Color fundus photograph: 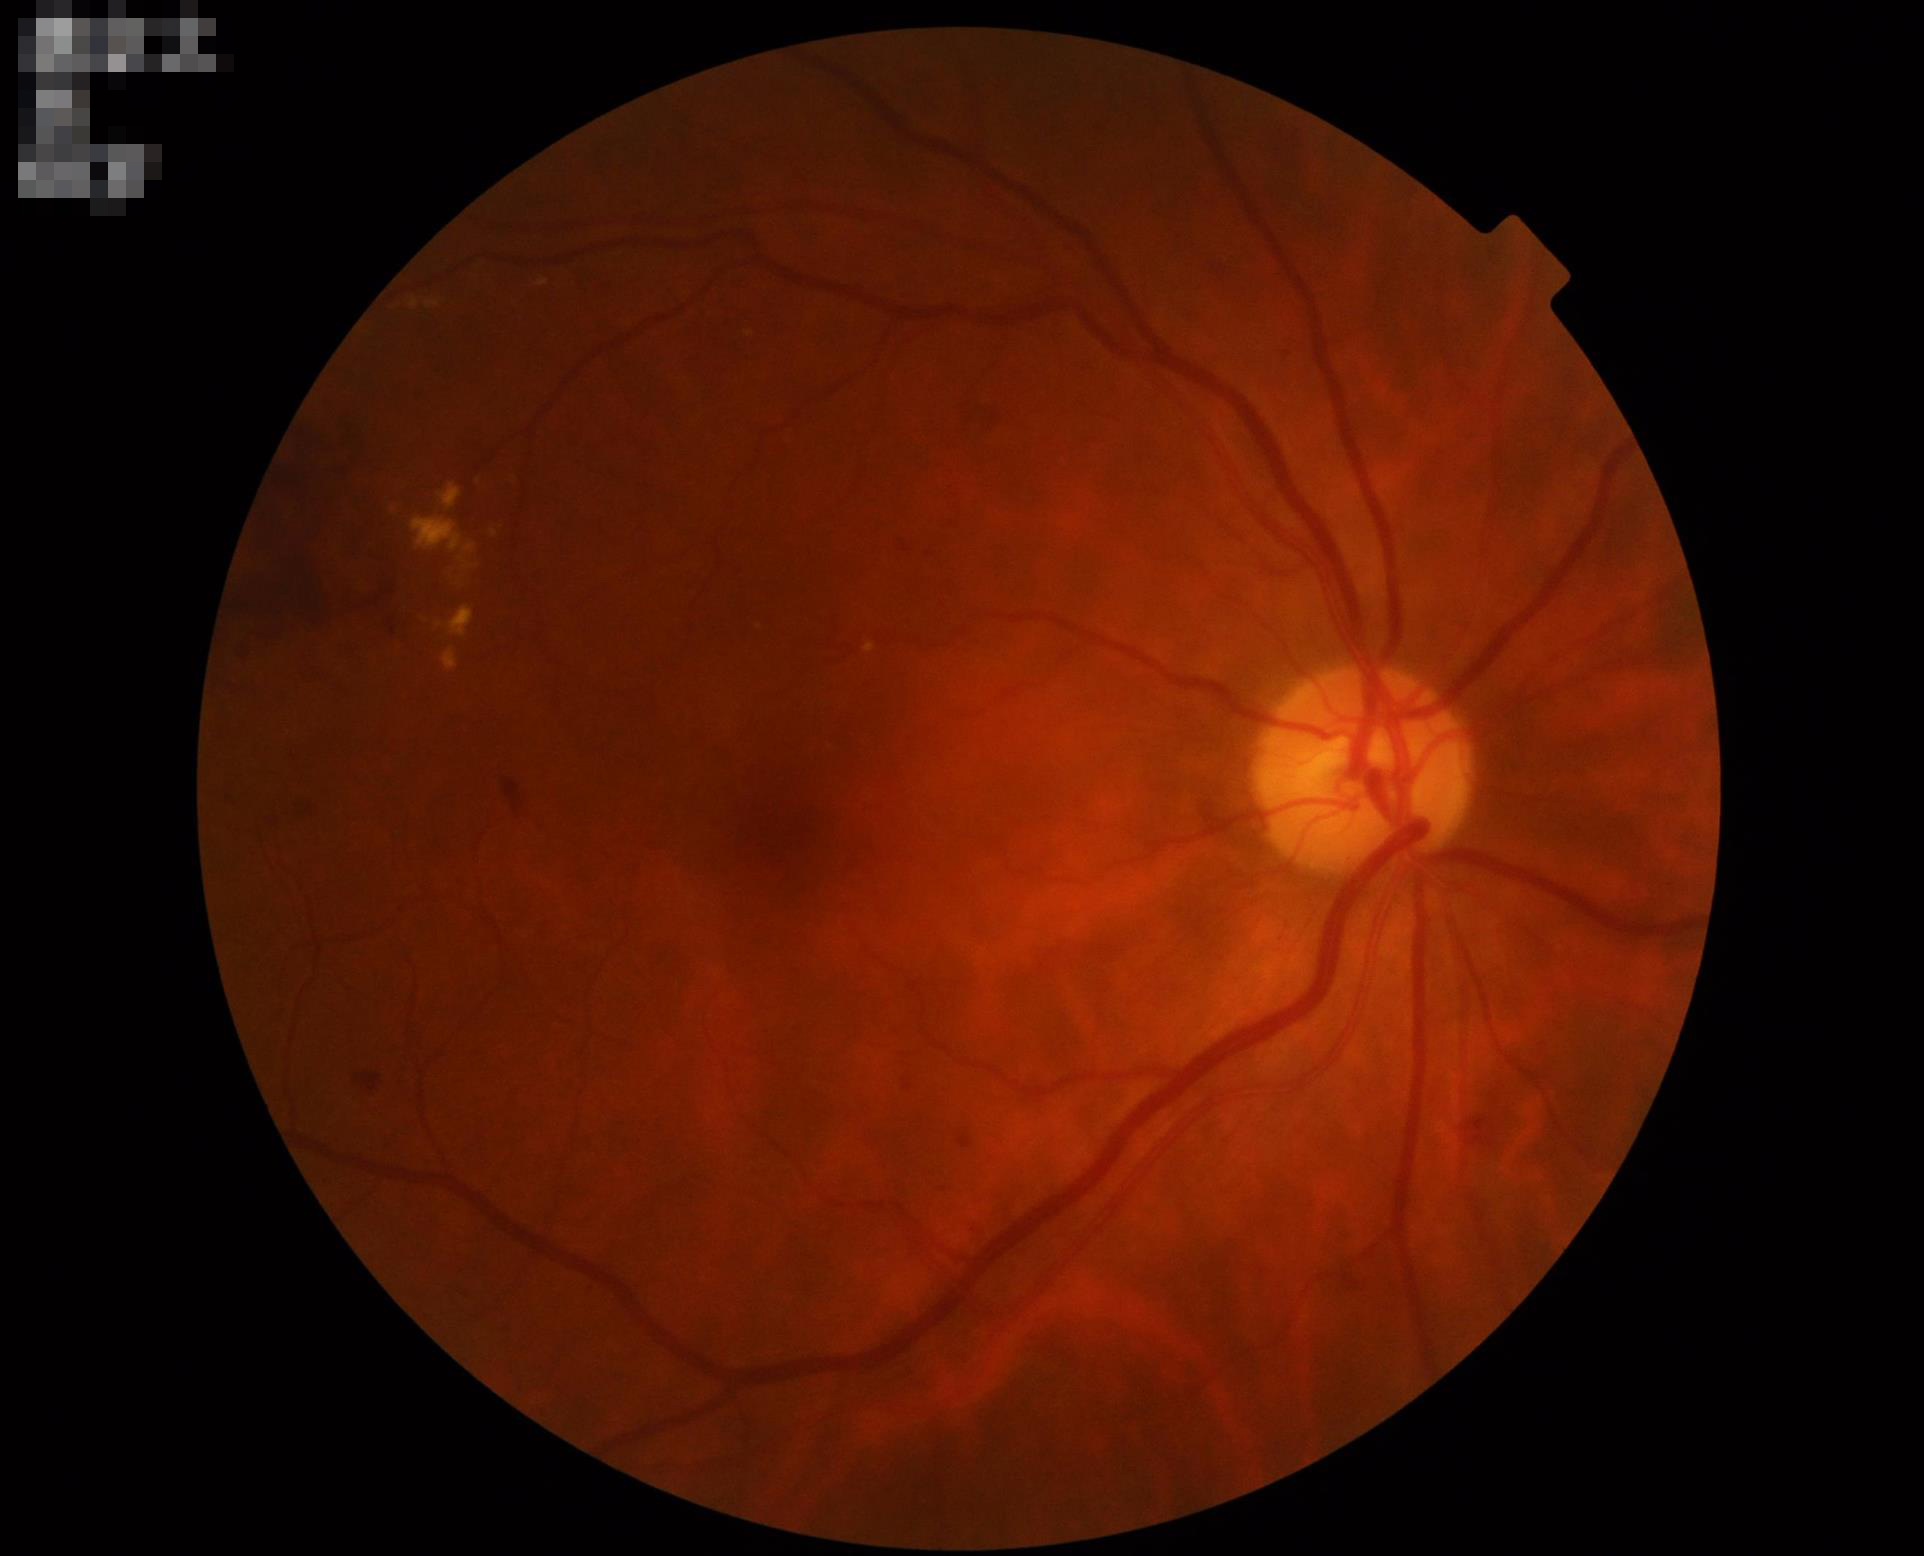 Overall: adequate for clinical interpretation
Illumination: uniform, no color cast
Clarity: clear with no noticeable blur